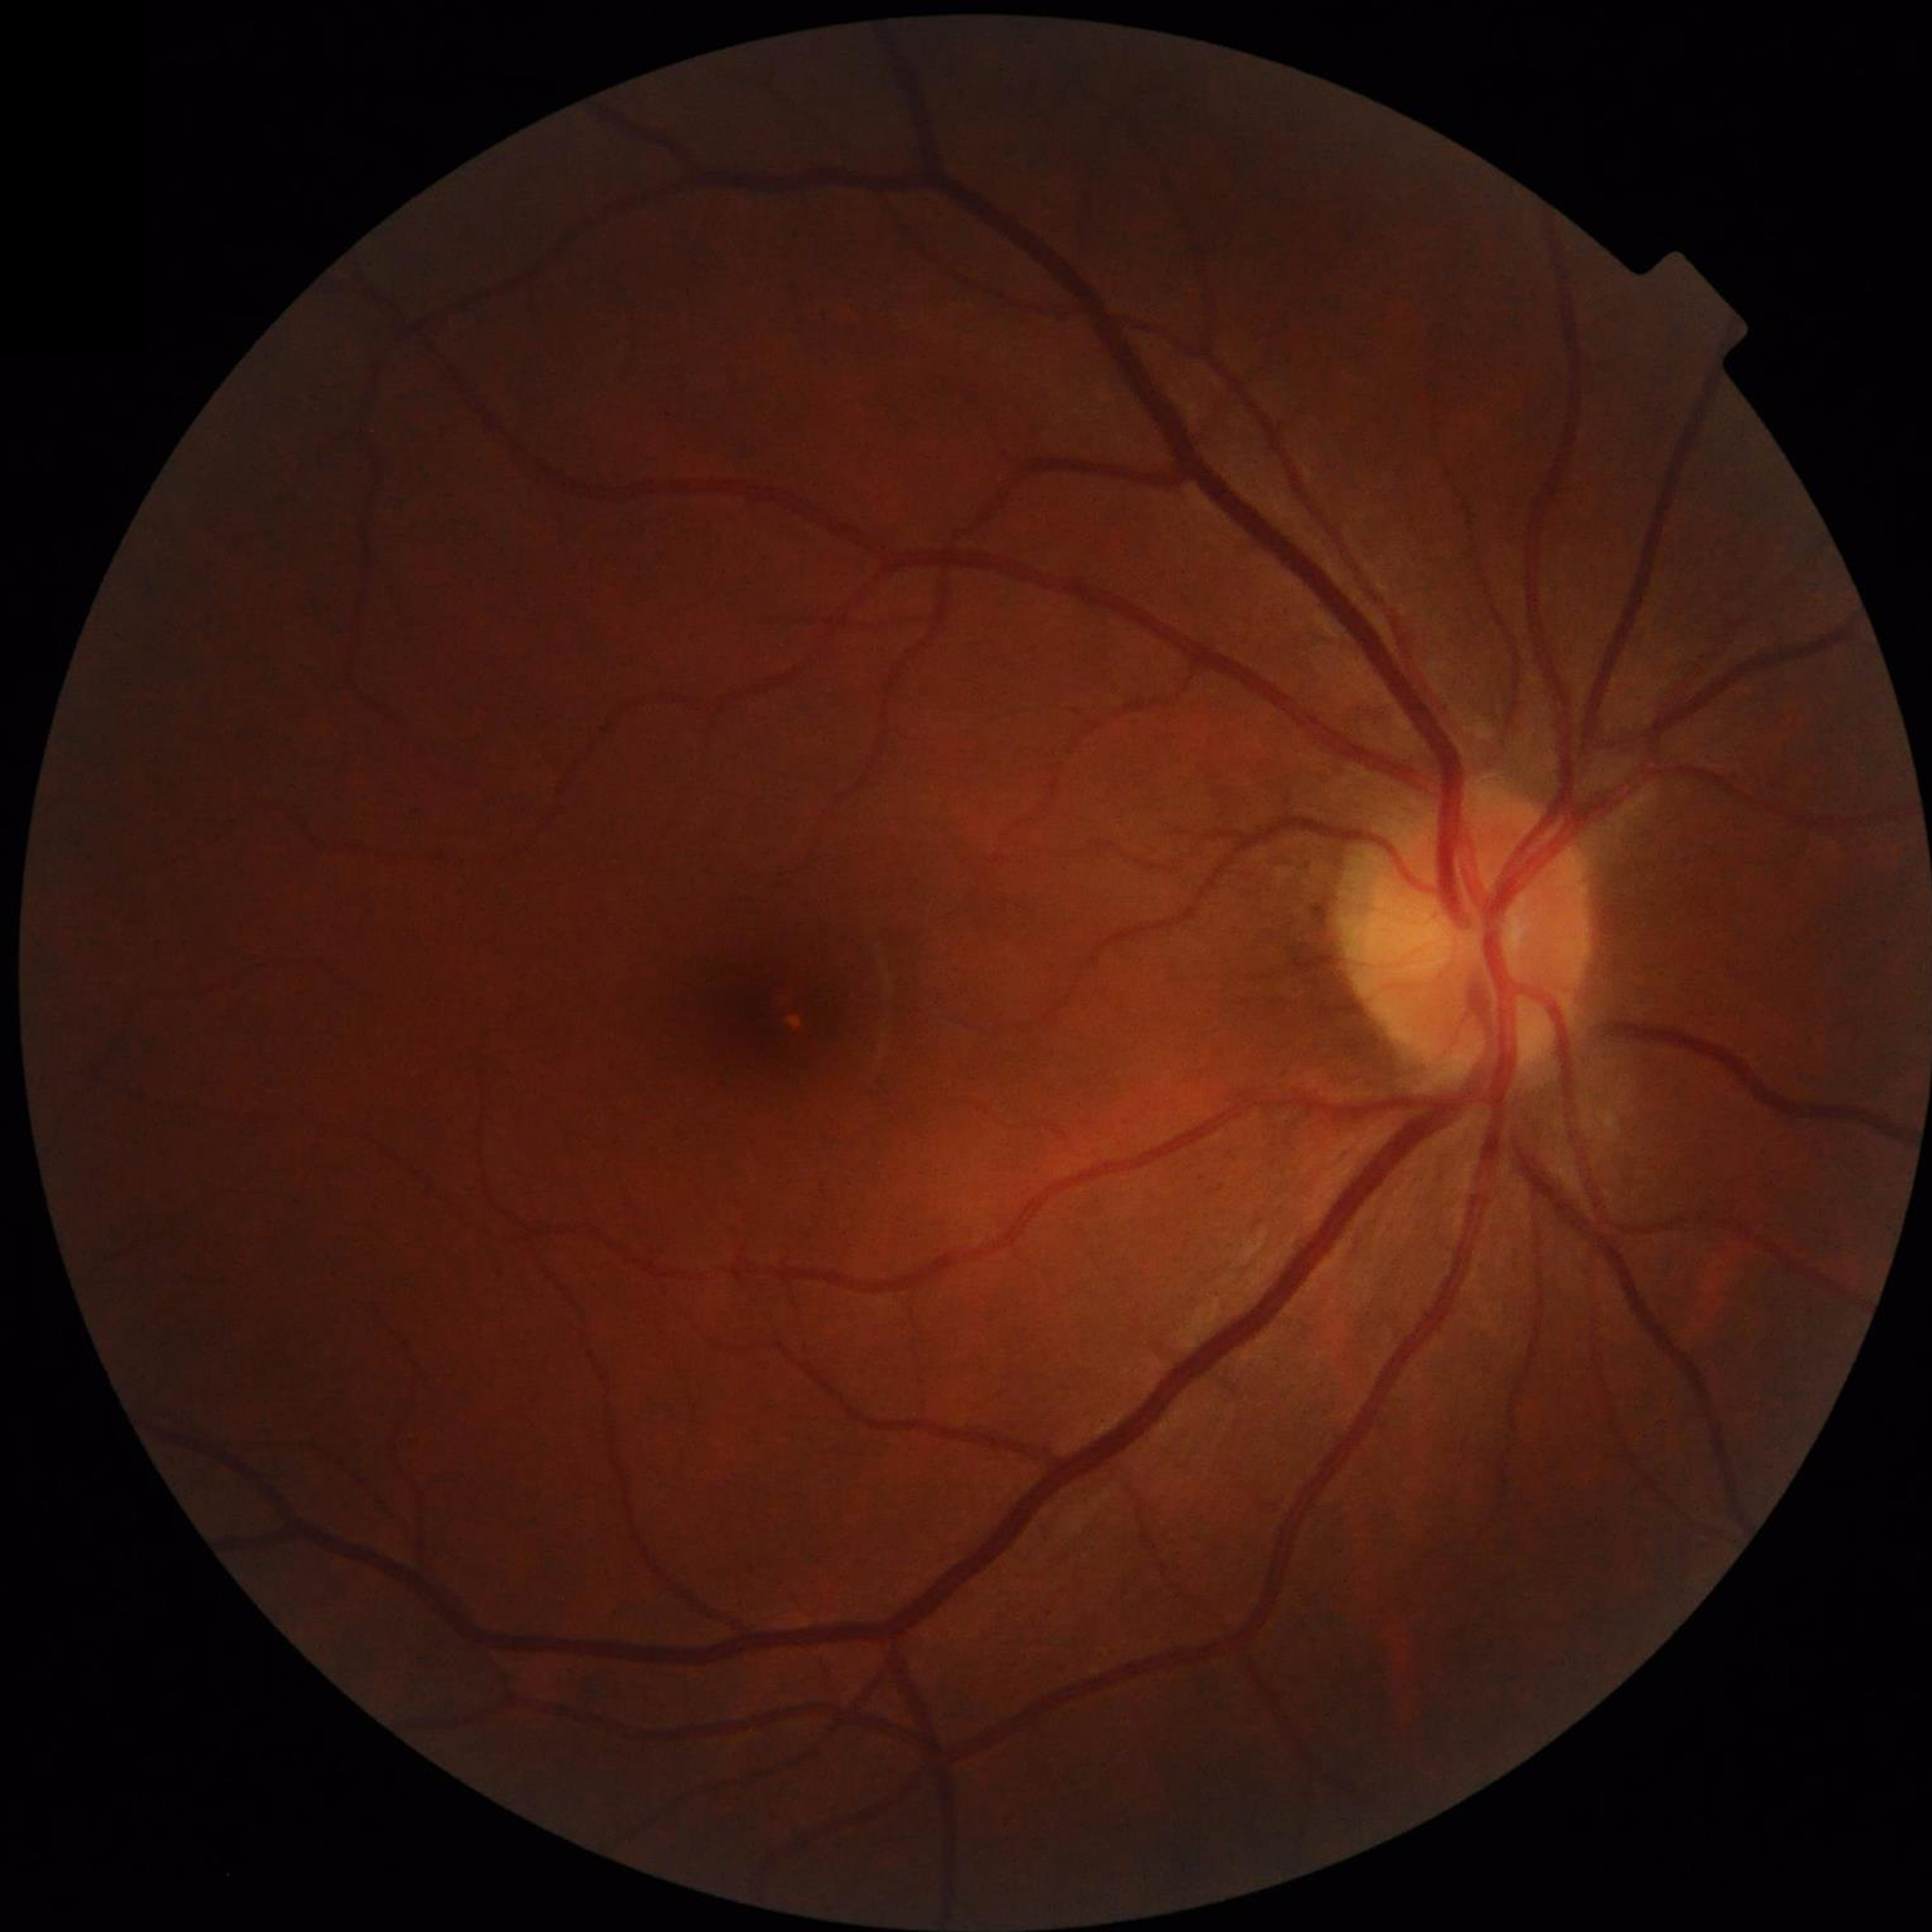 image_quality: adequate
diagnosis: no AMD, DR, or glaucomatous findings